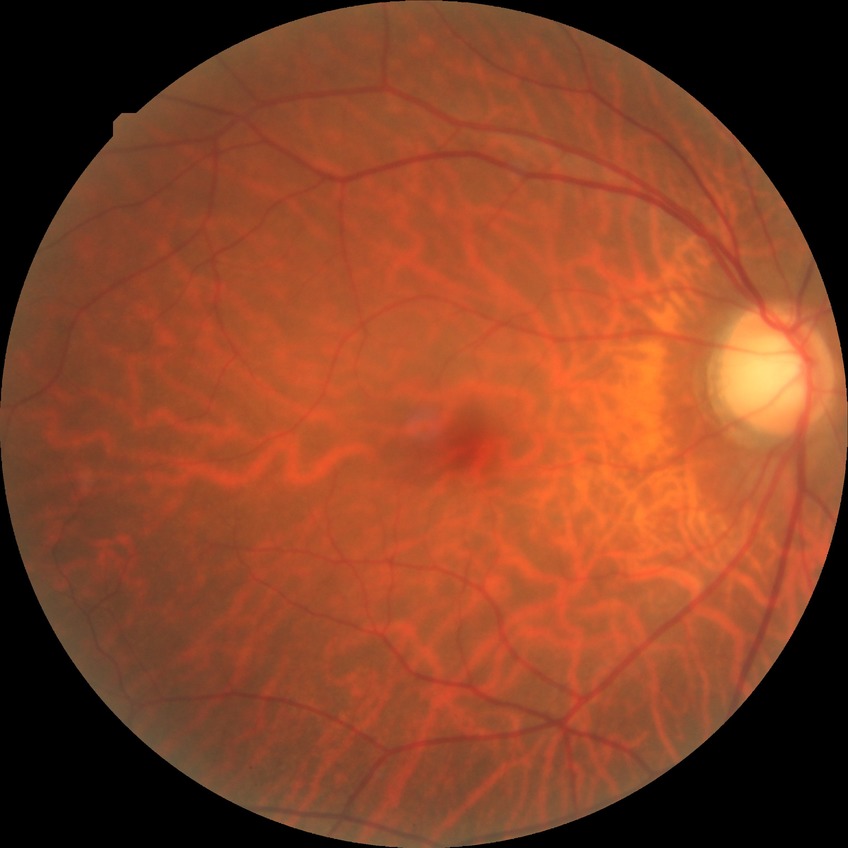
Diabetic retinopathy grade: no diabetic retinopathy.